45° FOV; Davis DR grading
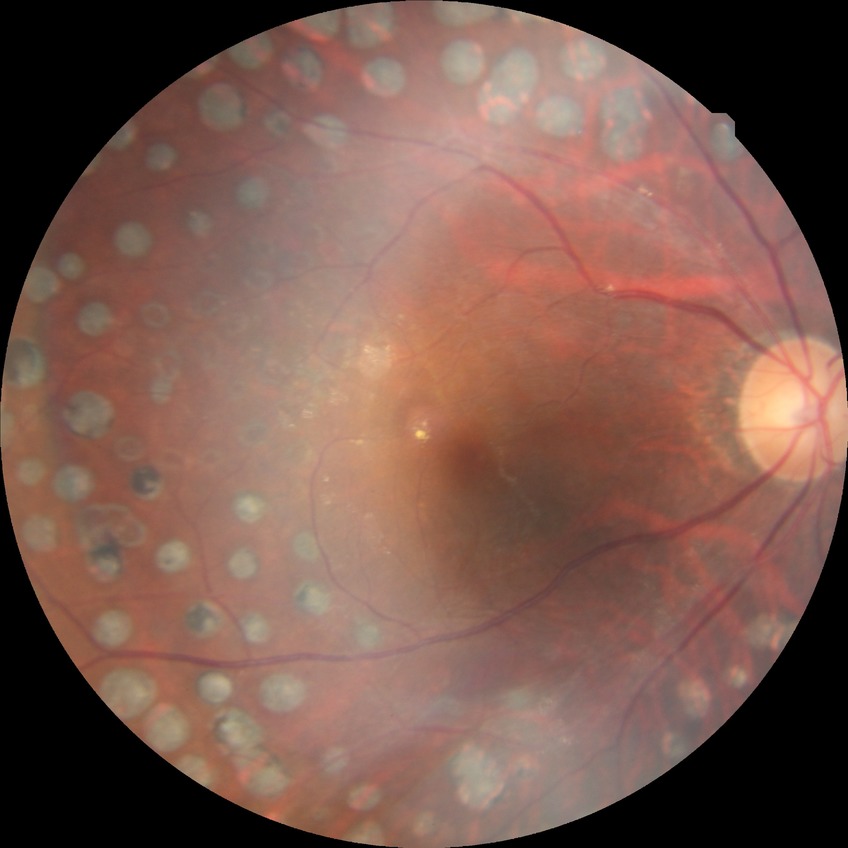
Diabetic retinopathy (DR): PDR (proliferative diabetic retinopathy).